Wide-field fundus photograph from neonatal ROP screening; acquired on the Phoenix ICON: 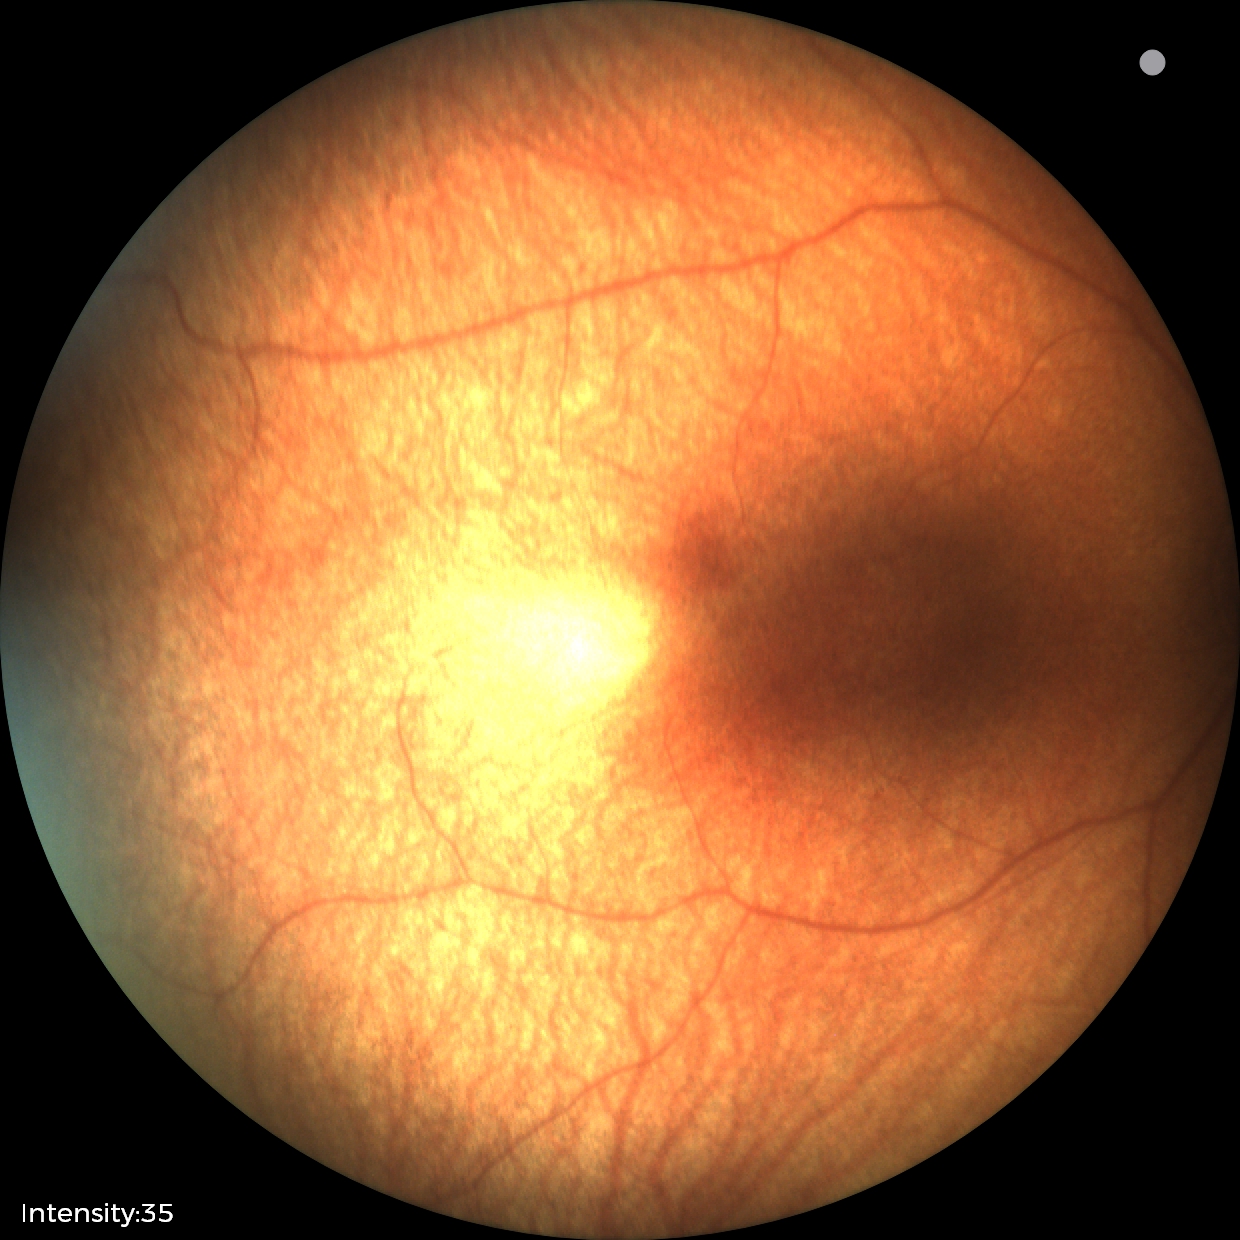

Assessment: no pathology identified